Infant wide-field retinal image:
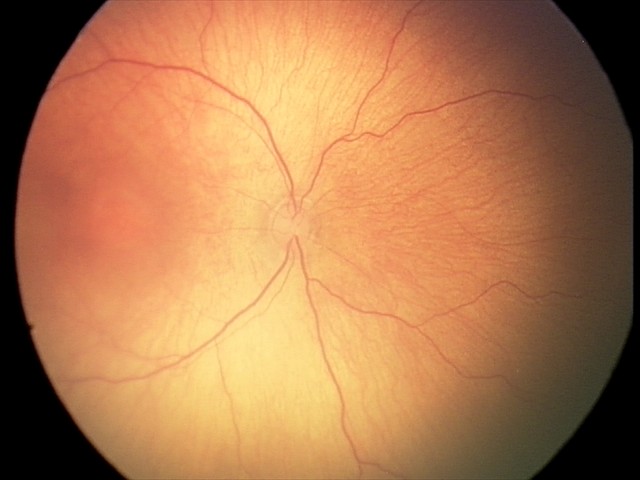

Diagnosis from this screening exam: ROP stage 2 — ridge with height and width at the demarcation line.
Without plus disease.